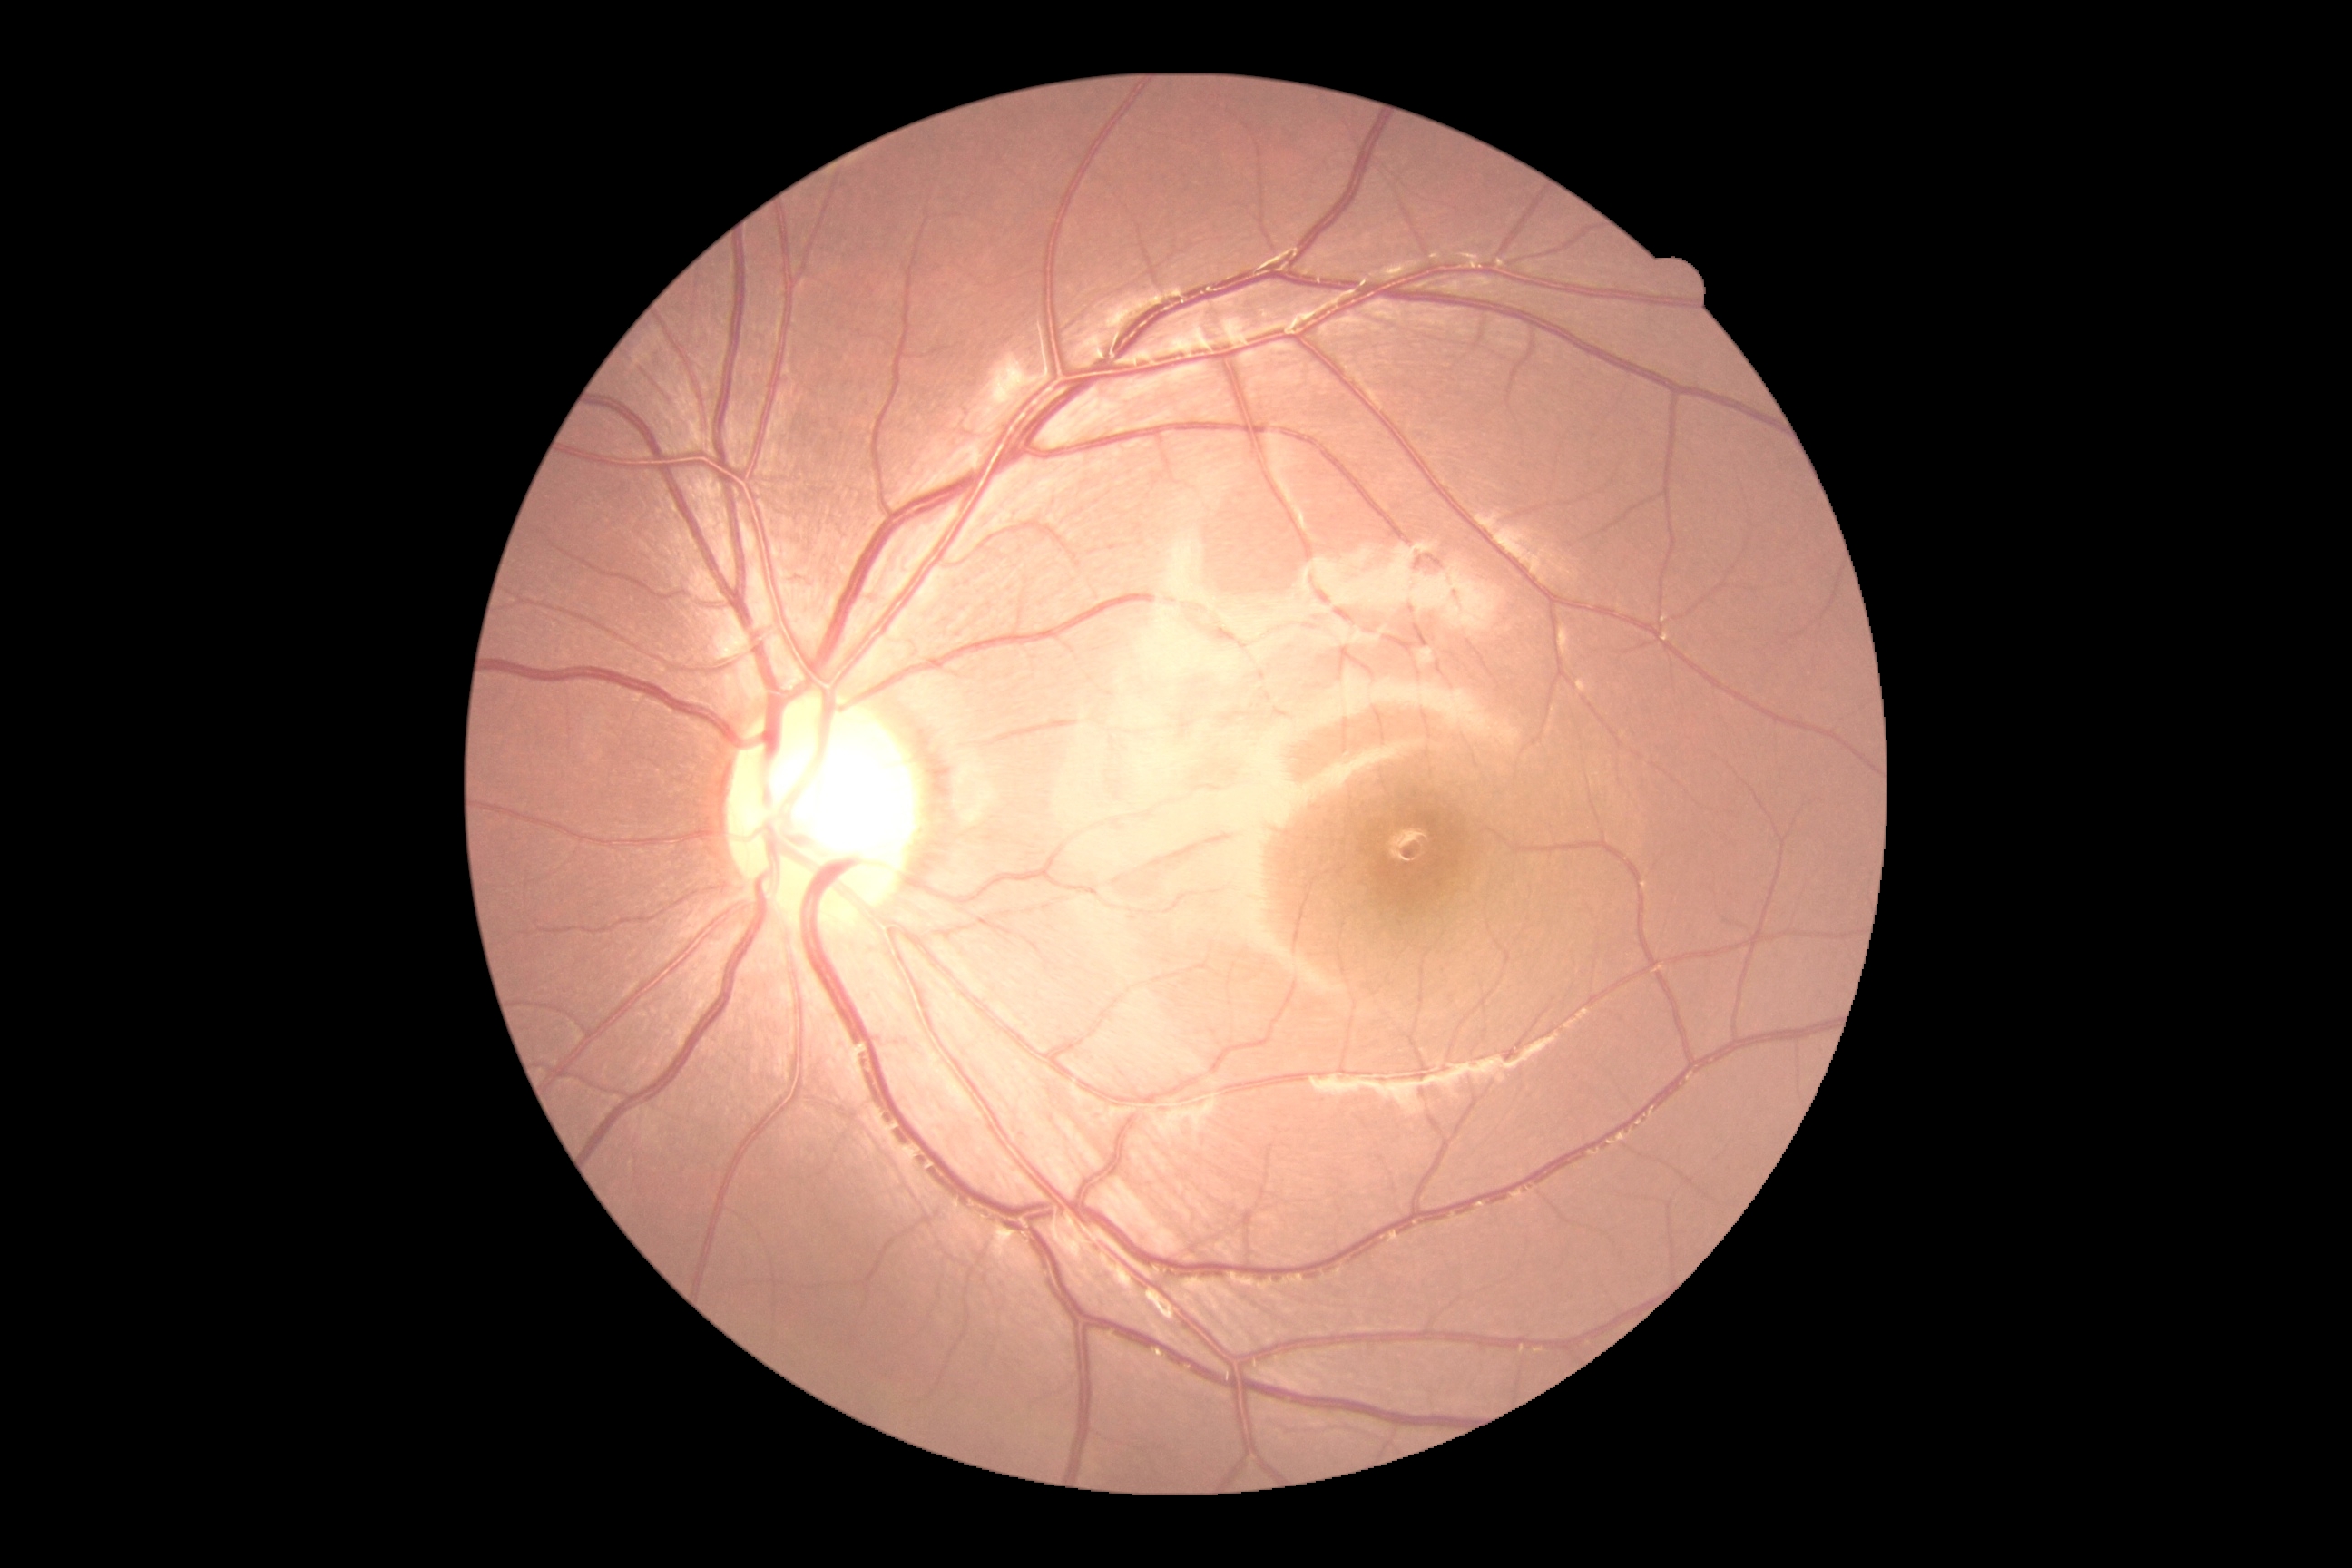

DR impression = no signs of DR, diabetic retinopathy (DR) = grade 0 (no apparent retinopathy).